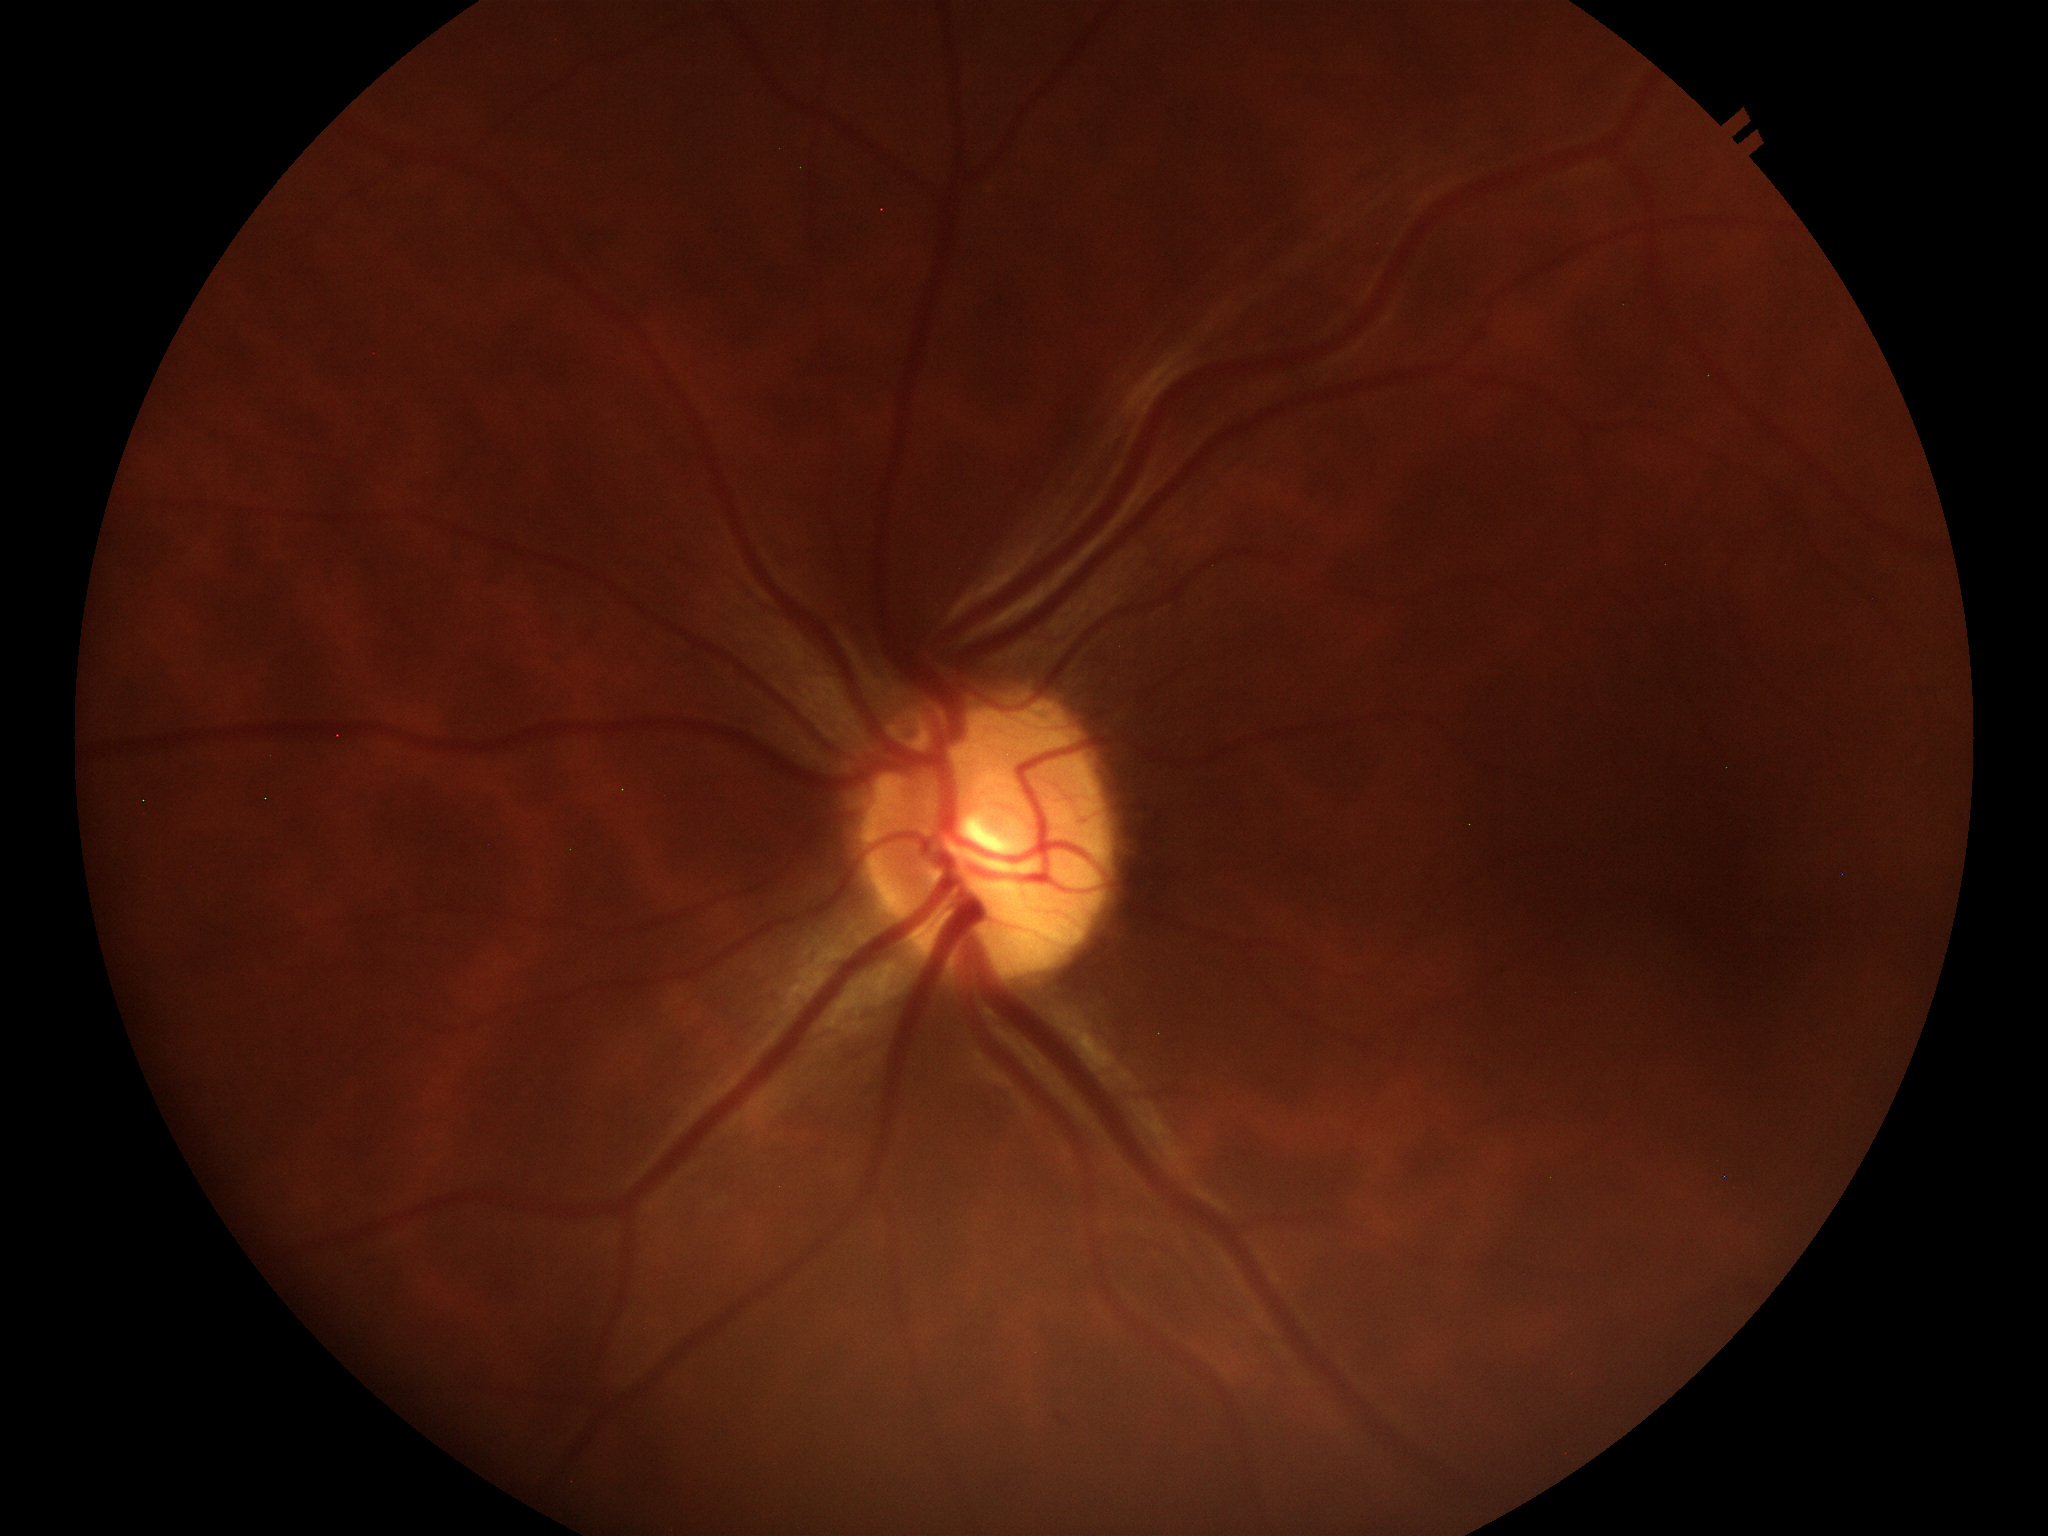
Optic disc analysis:
• Glaucoma impression — no suspicious findings
• vertical CDR (VCDR) — 0.46
• horizontal C/D ratio (HCDR) — 0.48